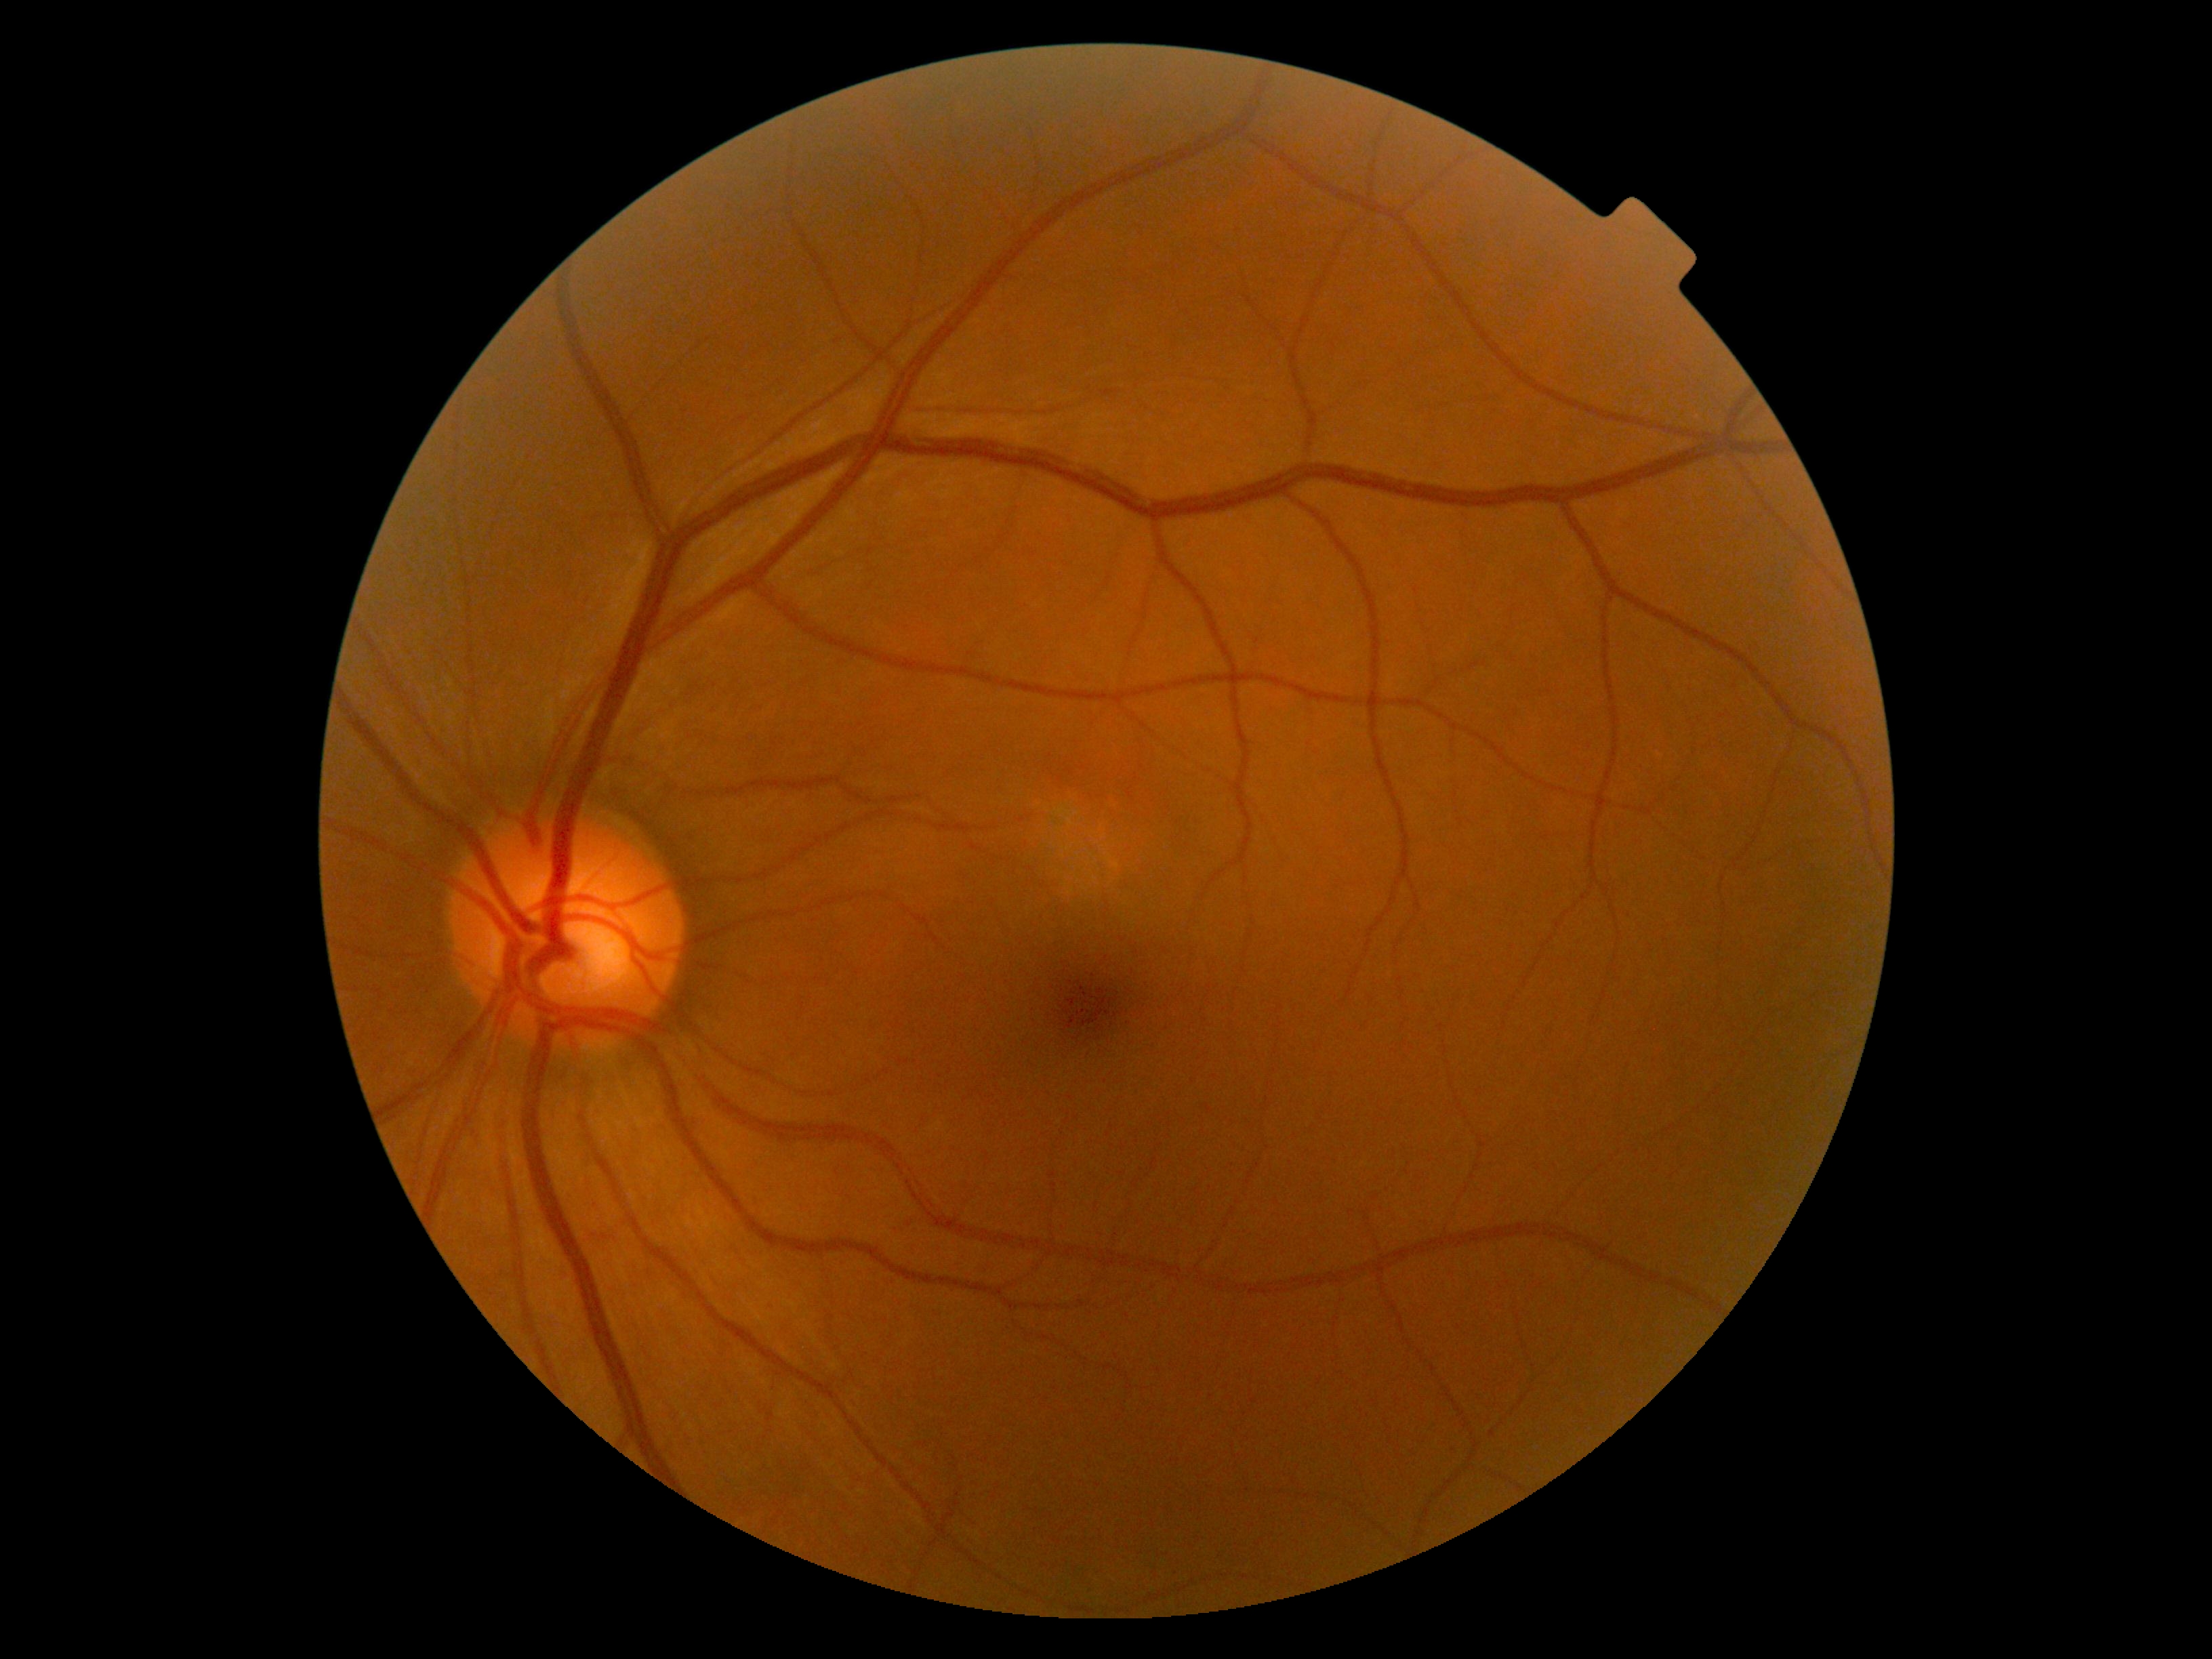
Diabetic retinopathy severity is grade 0. No DR findings.